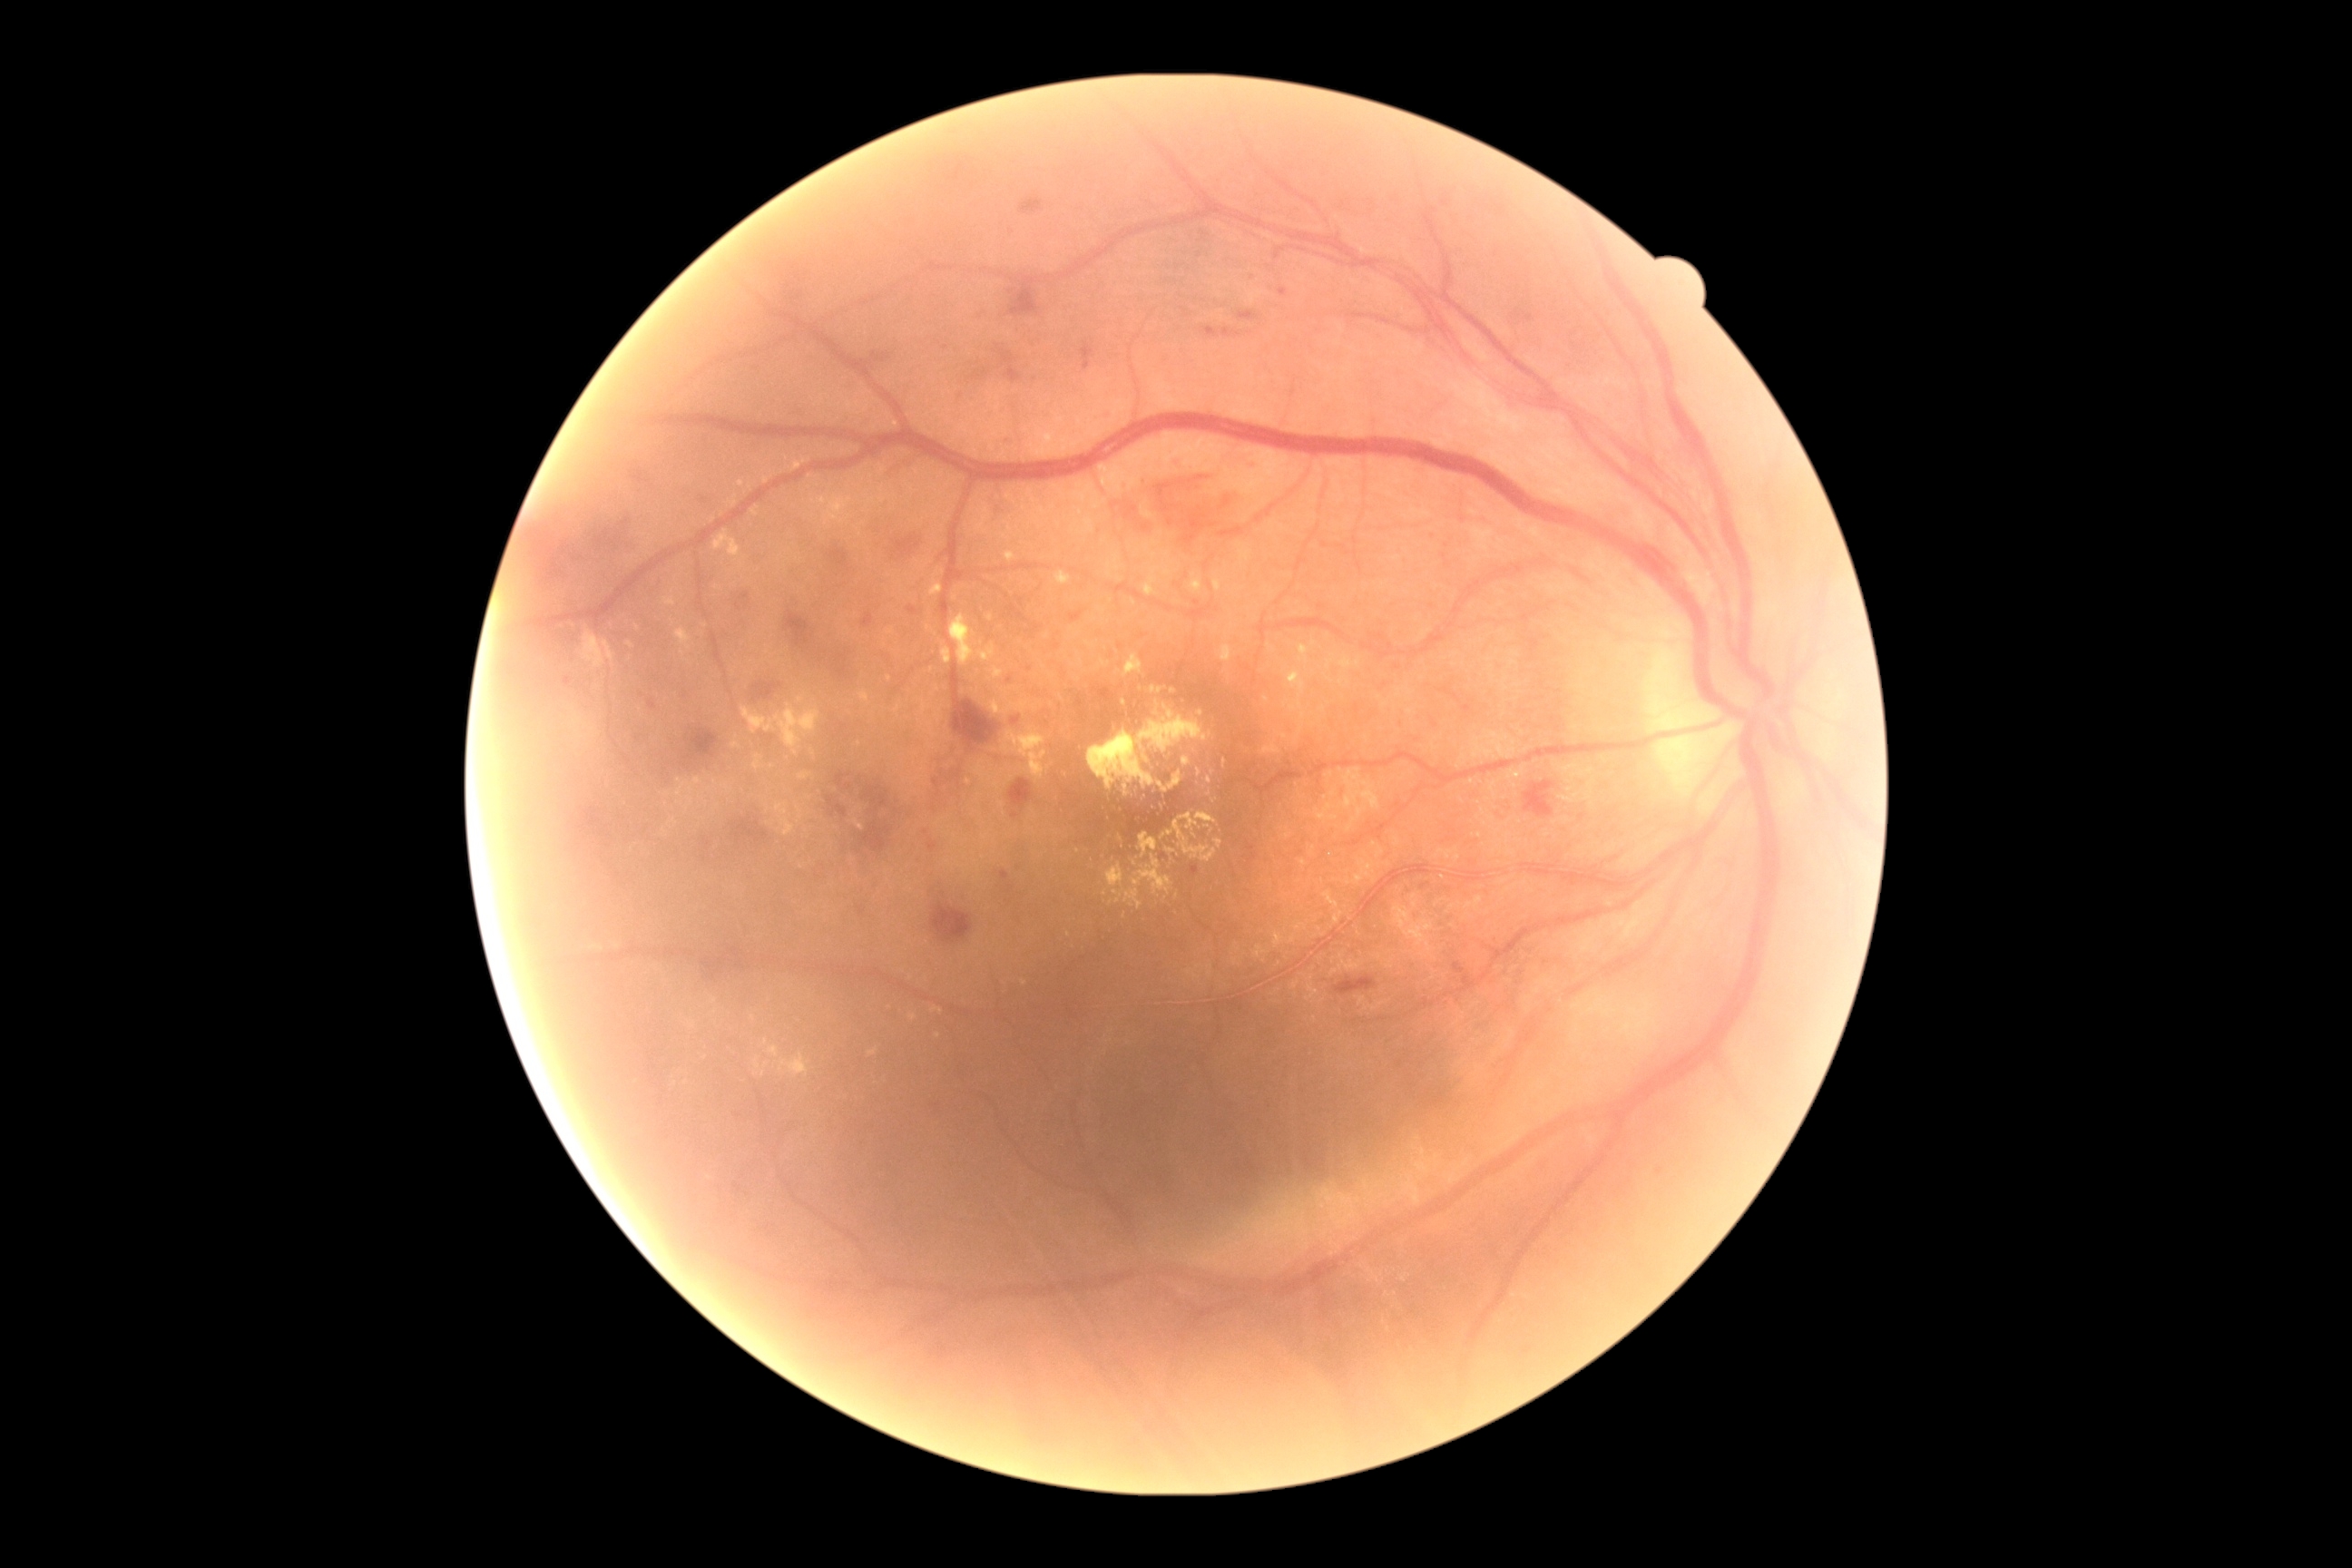
Diabetic retinopathy (DR): moderate NPDR (grade 2) — more than just microaneurysms but less than severe NPDR; non-proliferative diabetic retinopathy
Representative lesions:
hard exudates (EXs) (subset): (x1=1326, y1=660, x2=1333, y2=669) | (x1=1260, y1=741, x2=1280, y2=756) | (x1=685, y1=796, x2=694, y2=812) | (x1=714, y1=531, x2=741, y2=562) | (x1=1003, y1=729, x2=1048, y2=779) | (x1=1271, y1=937, x2=1282, y2=948) | (x1=1253, y1=950, x2=1269, y2=963) | (x1=1139, y1=832, x2=1157, y2=859) | (x1=1101, y1=660, x2=1110, y2=669) | (x1=669, y1=819, x2=678, y2=825)
Additional small EXs near 1005, 536 | 1209, 794 | 668, 795 | 859, 745 | 859, 809 | 709, 790 | 1023, 983 | 679, 781